Modified Davis grading. Without pupil dilation: 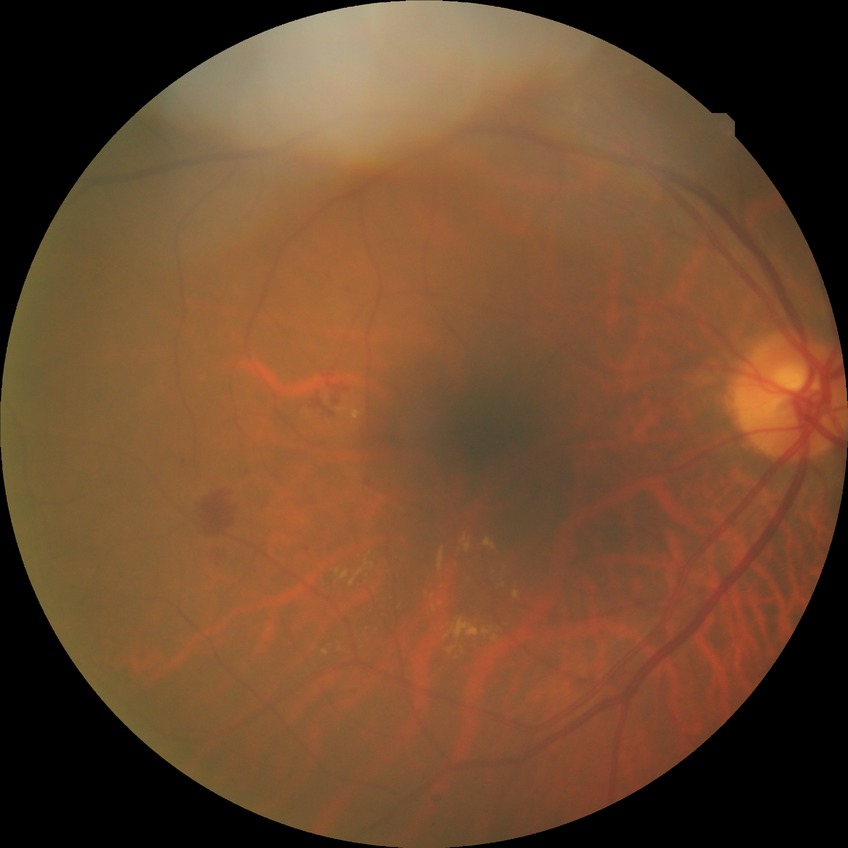

* diabetic retinopathy (DR): SDR (simple diabetic retinopathy)
* DR class: non-proliferative diabetic retinopathy